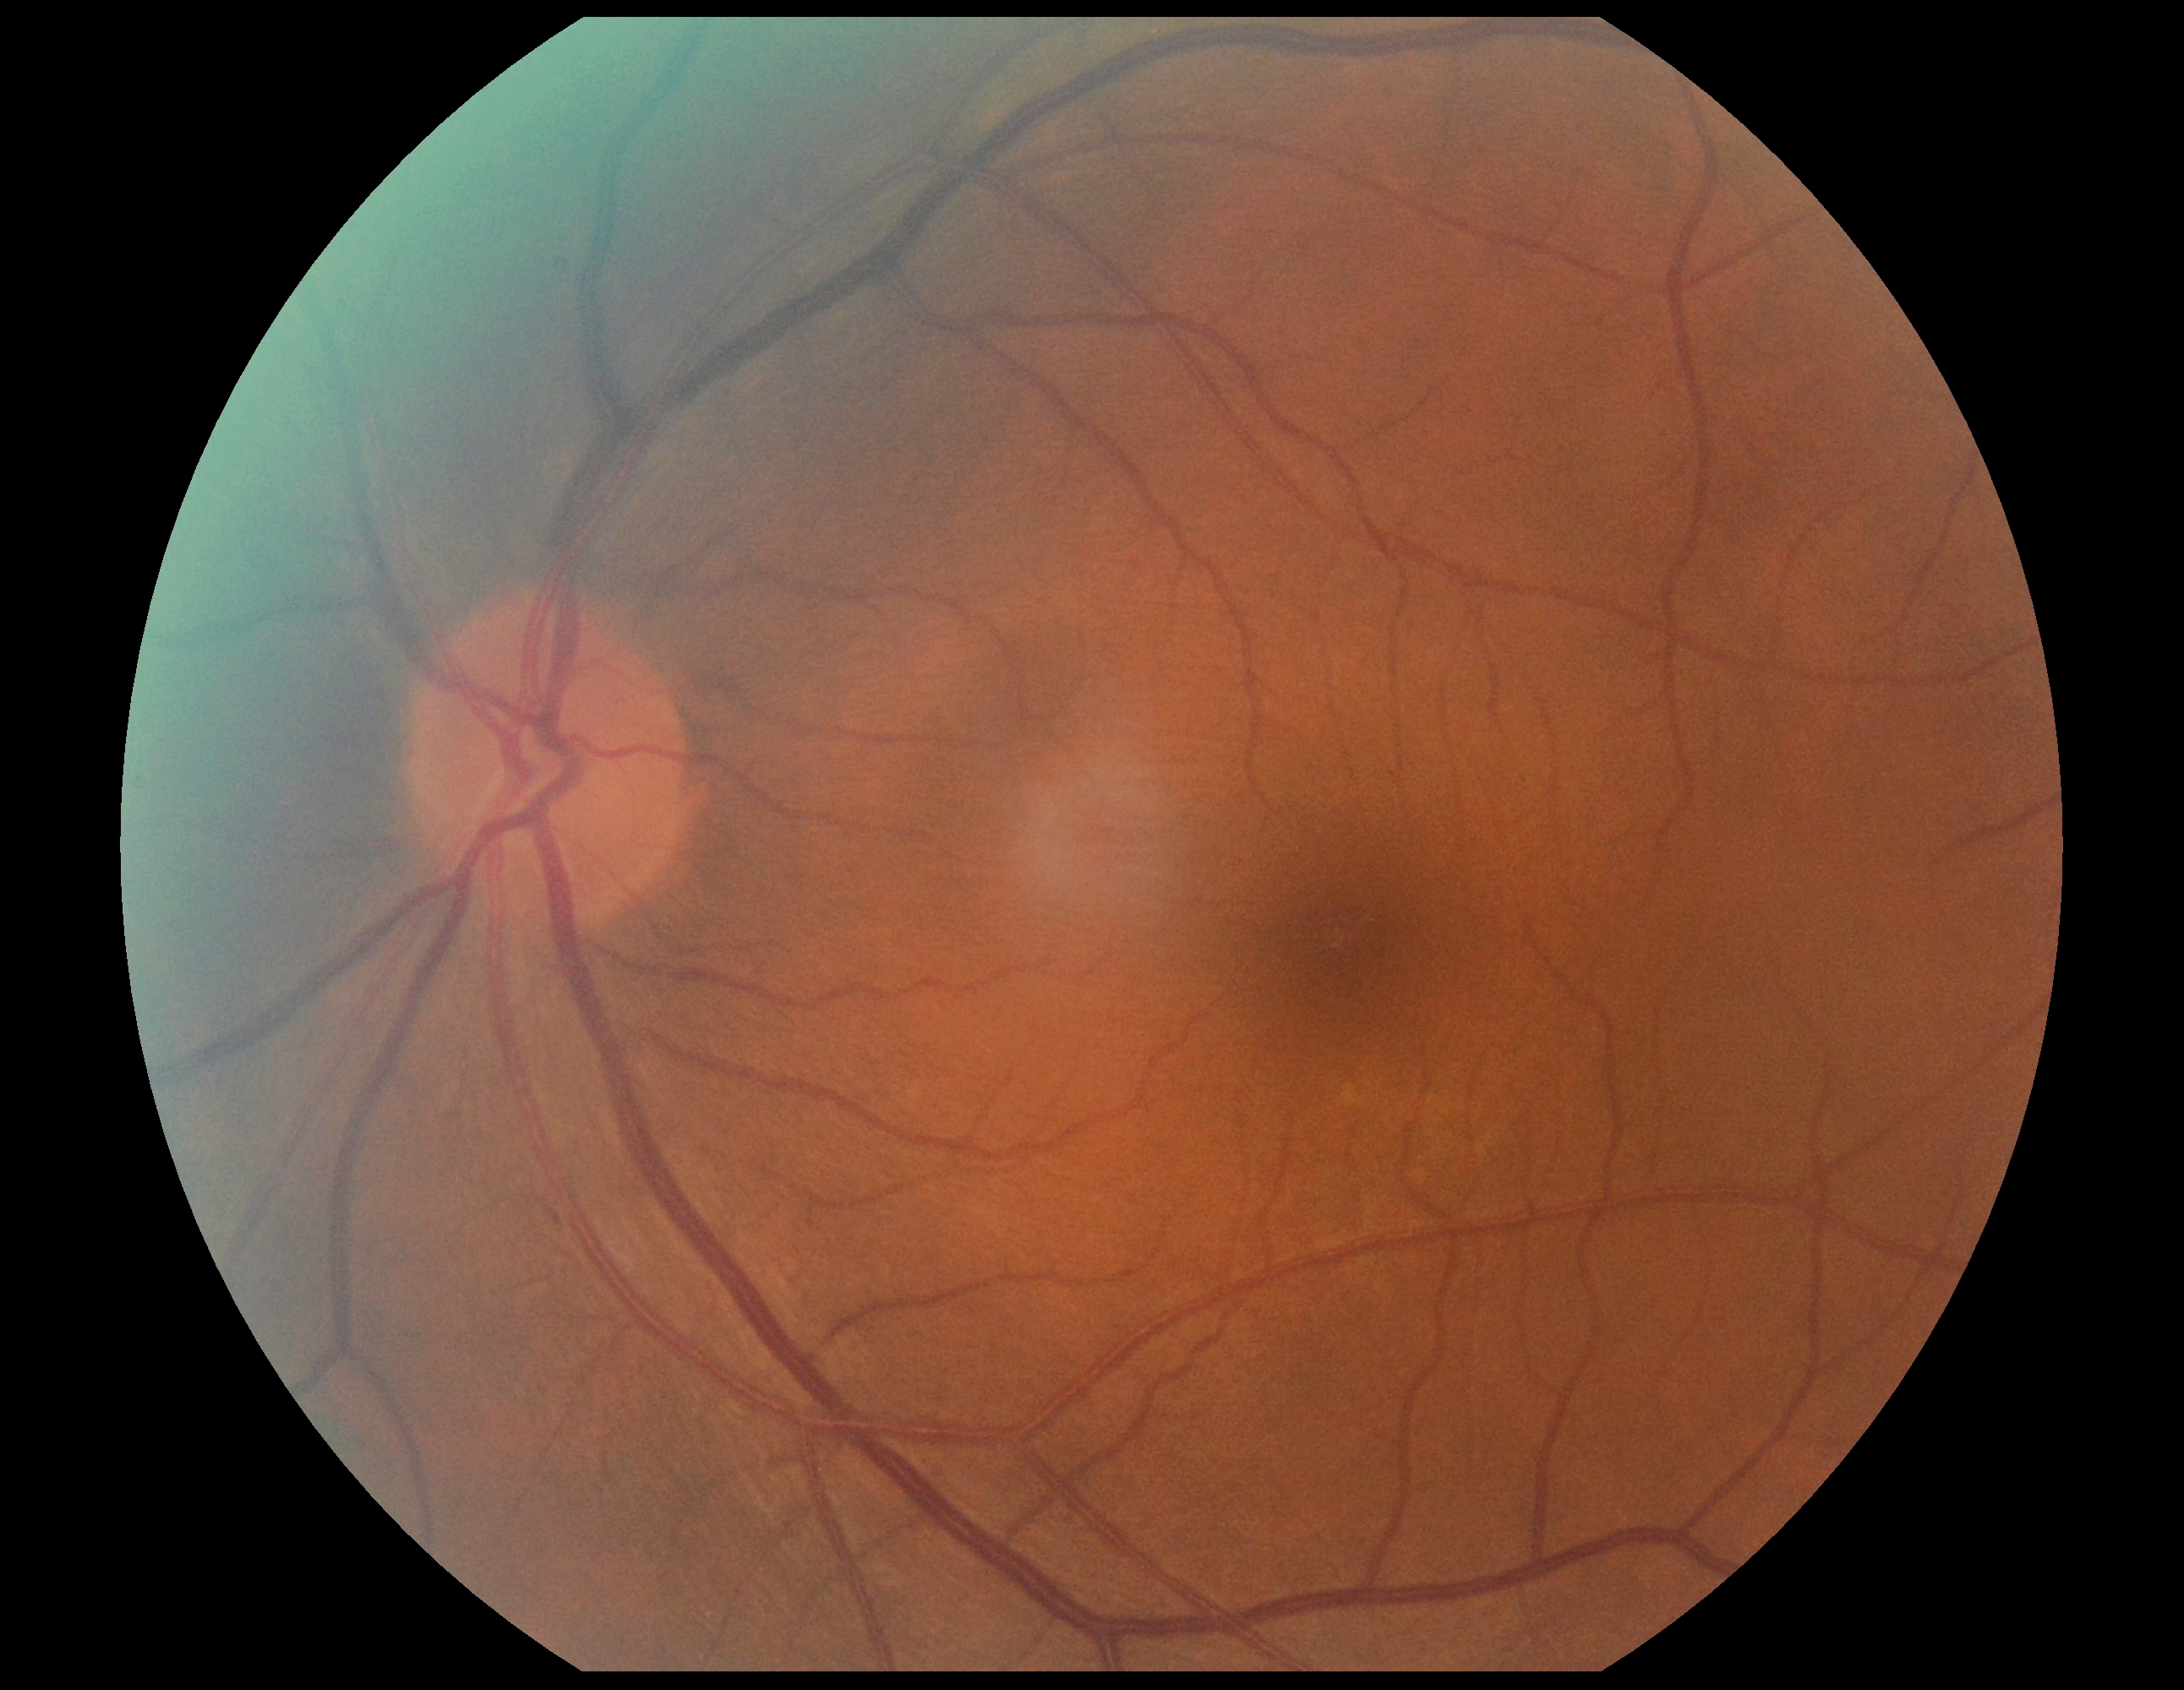

DR severity is grade 1.